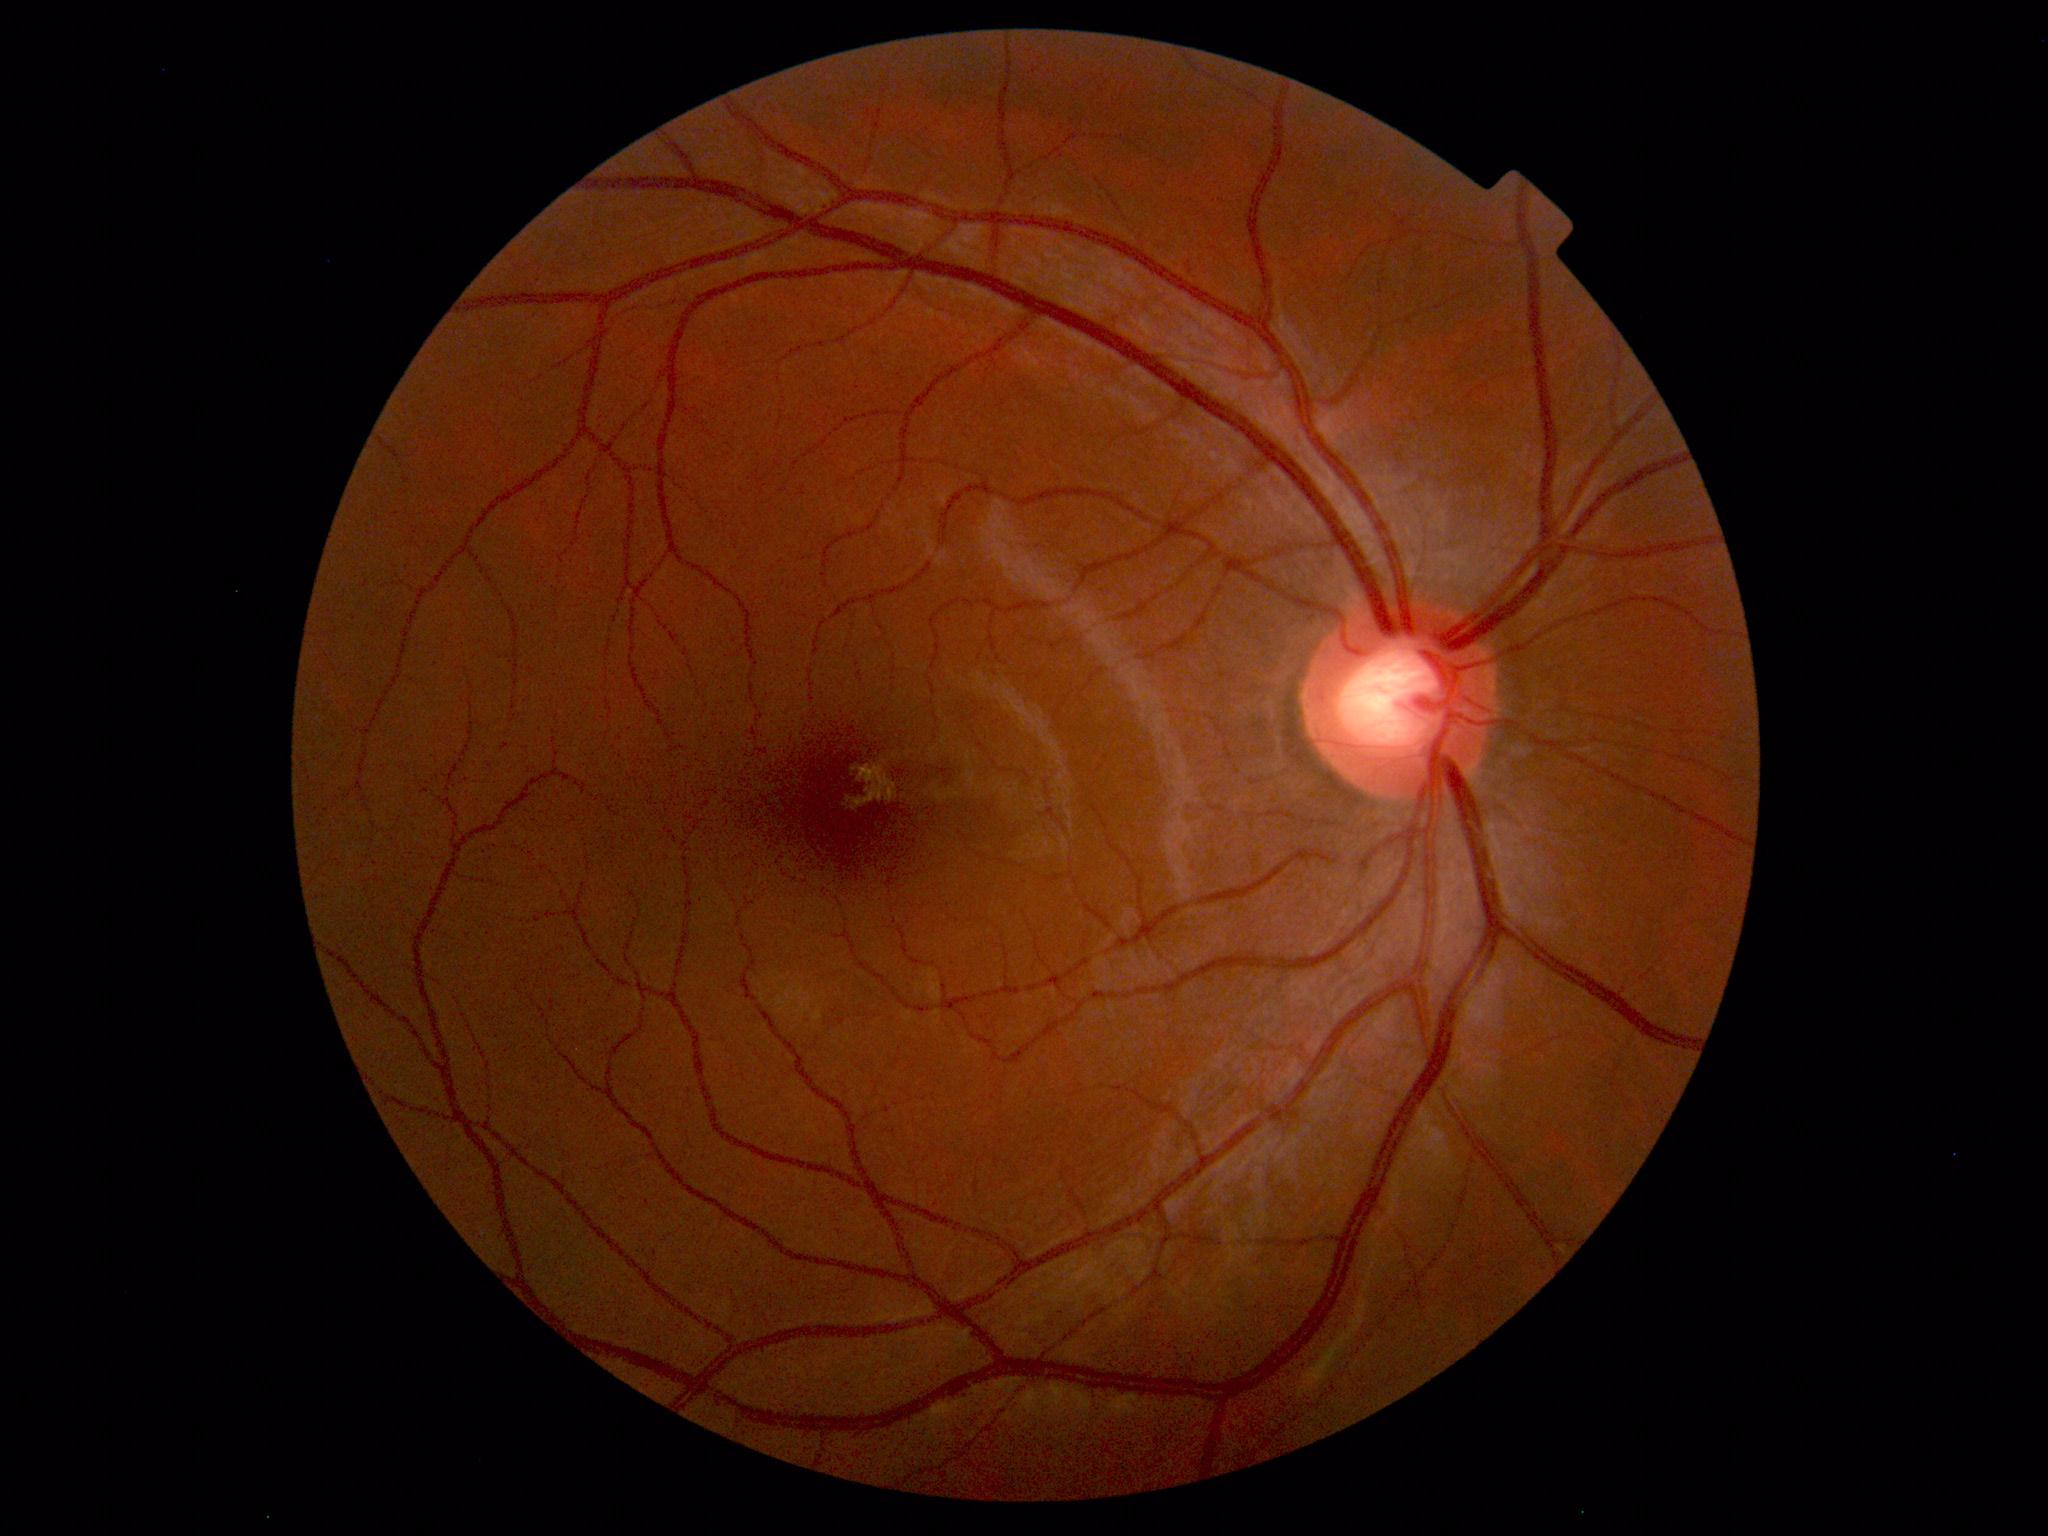
Normal fundus appearance.